No pharmacologic dilation, FOV: 45 degrees:
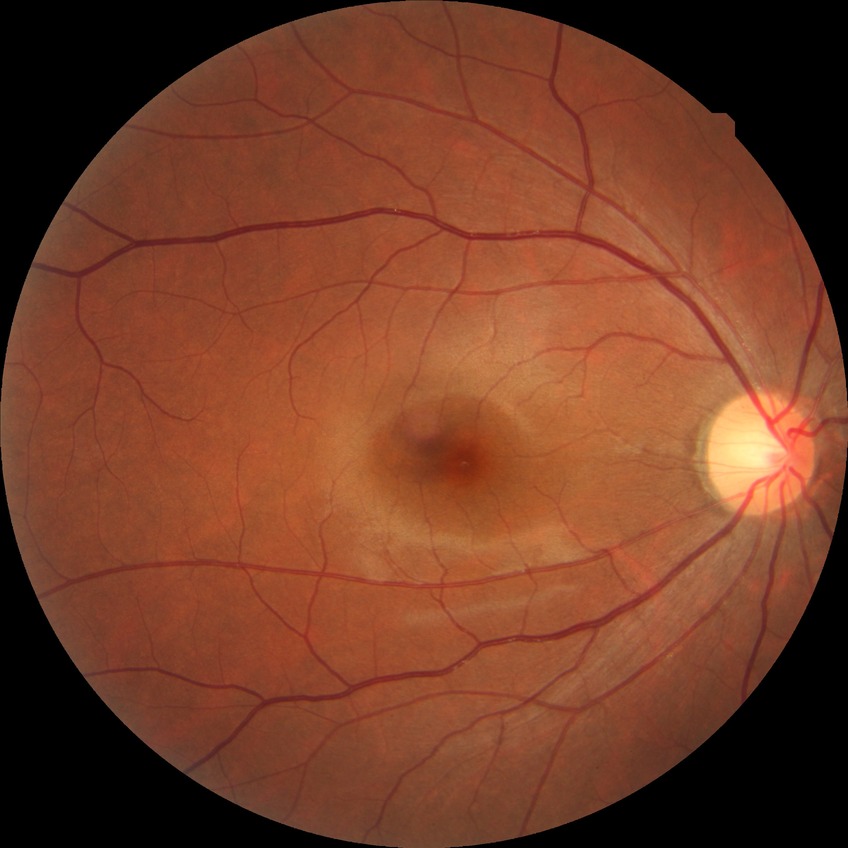 Diabetic retinopathy (DR) is NDR (no diabetic retinopathy).